1924x1556px:
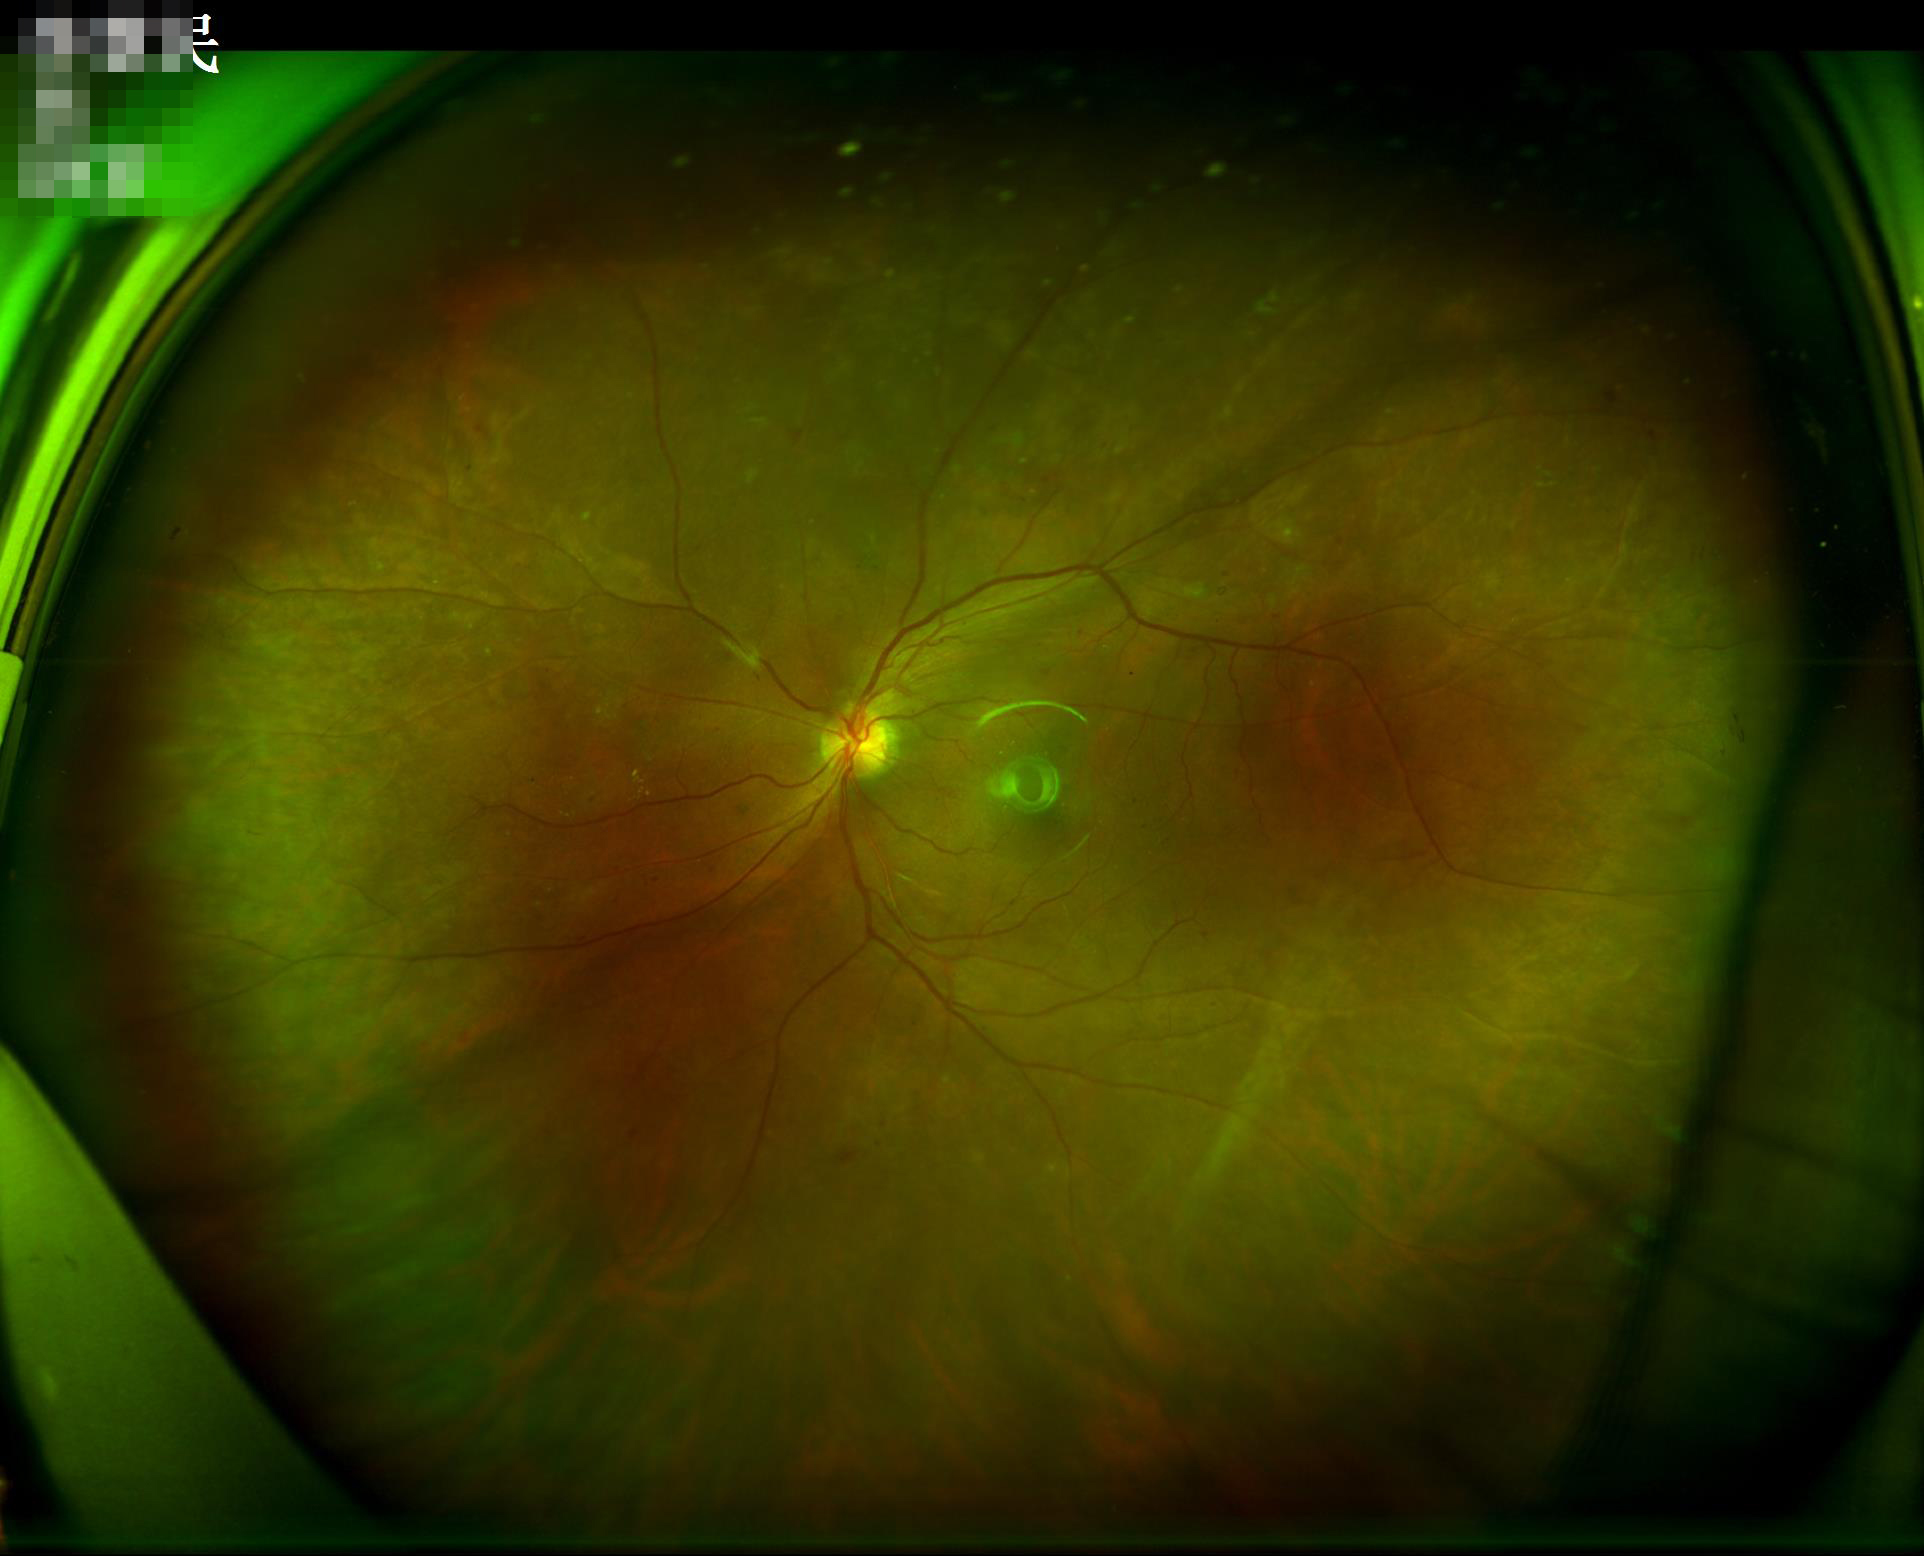
Image quality: overall: good | contrast: satisfactory | sharpness: good.